Pediatric wide-field fundus photograph:
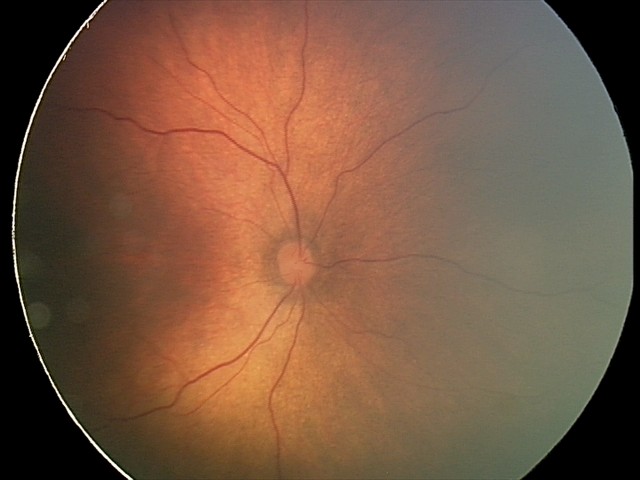
Screening series with status post ROP.